Retinal fundus photograph — 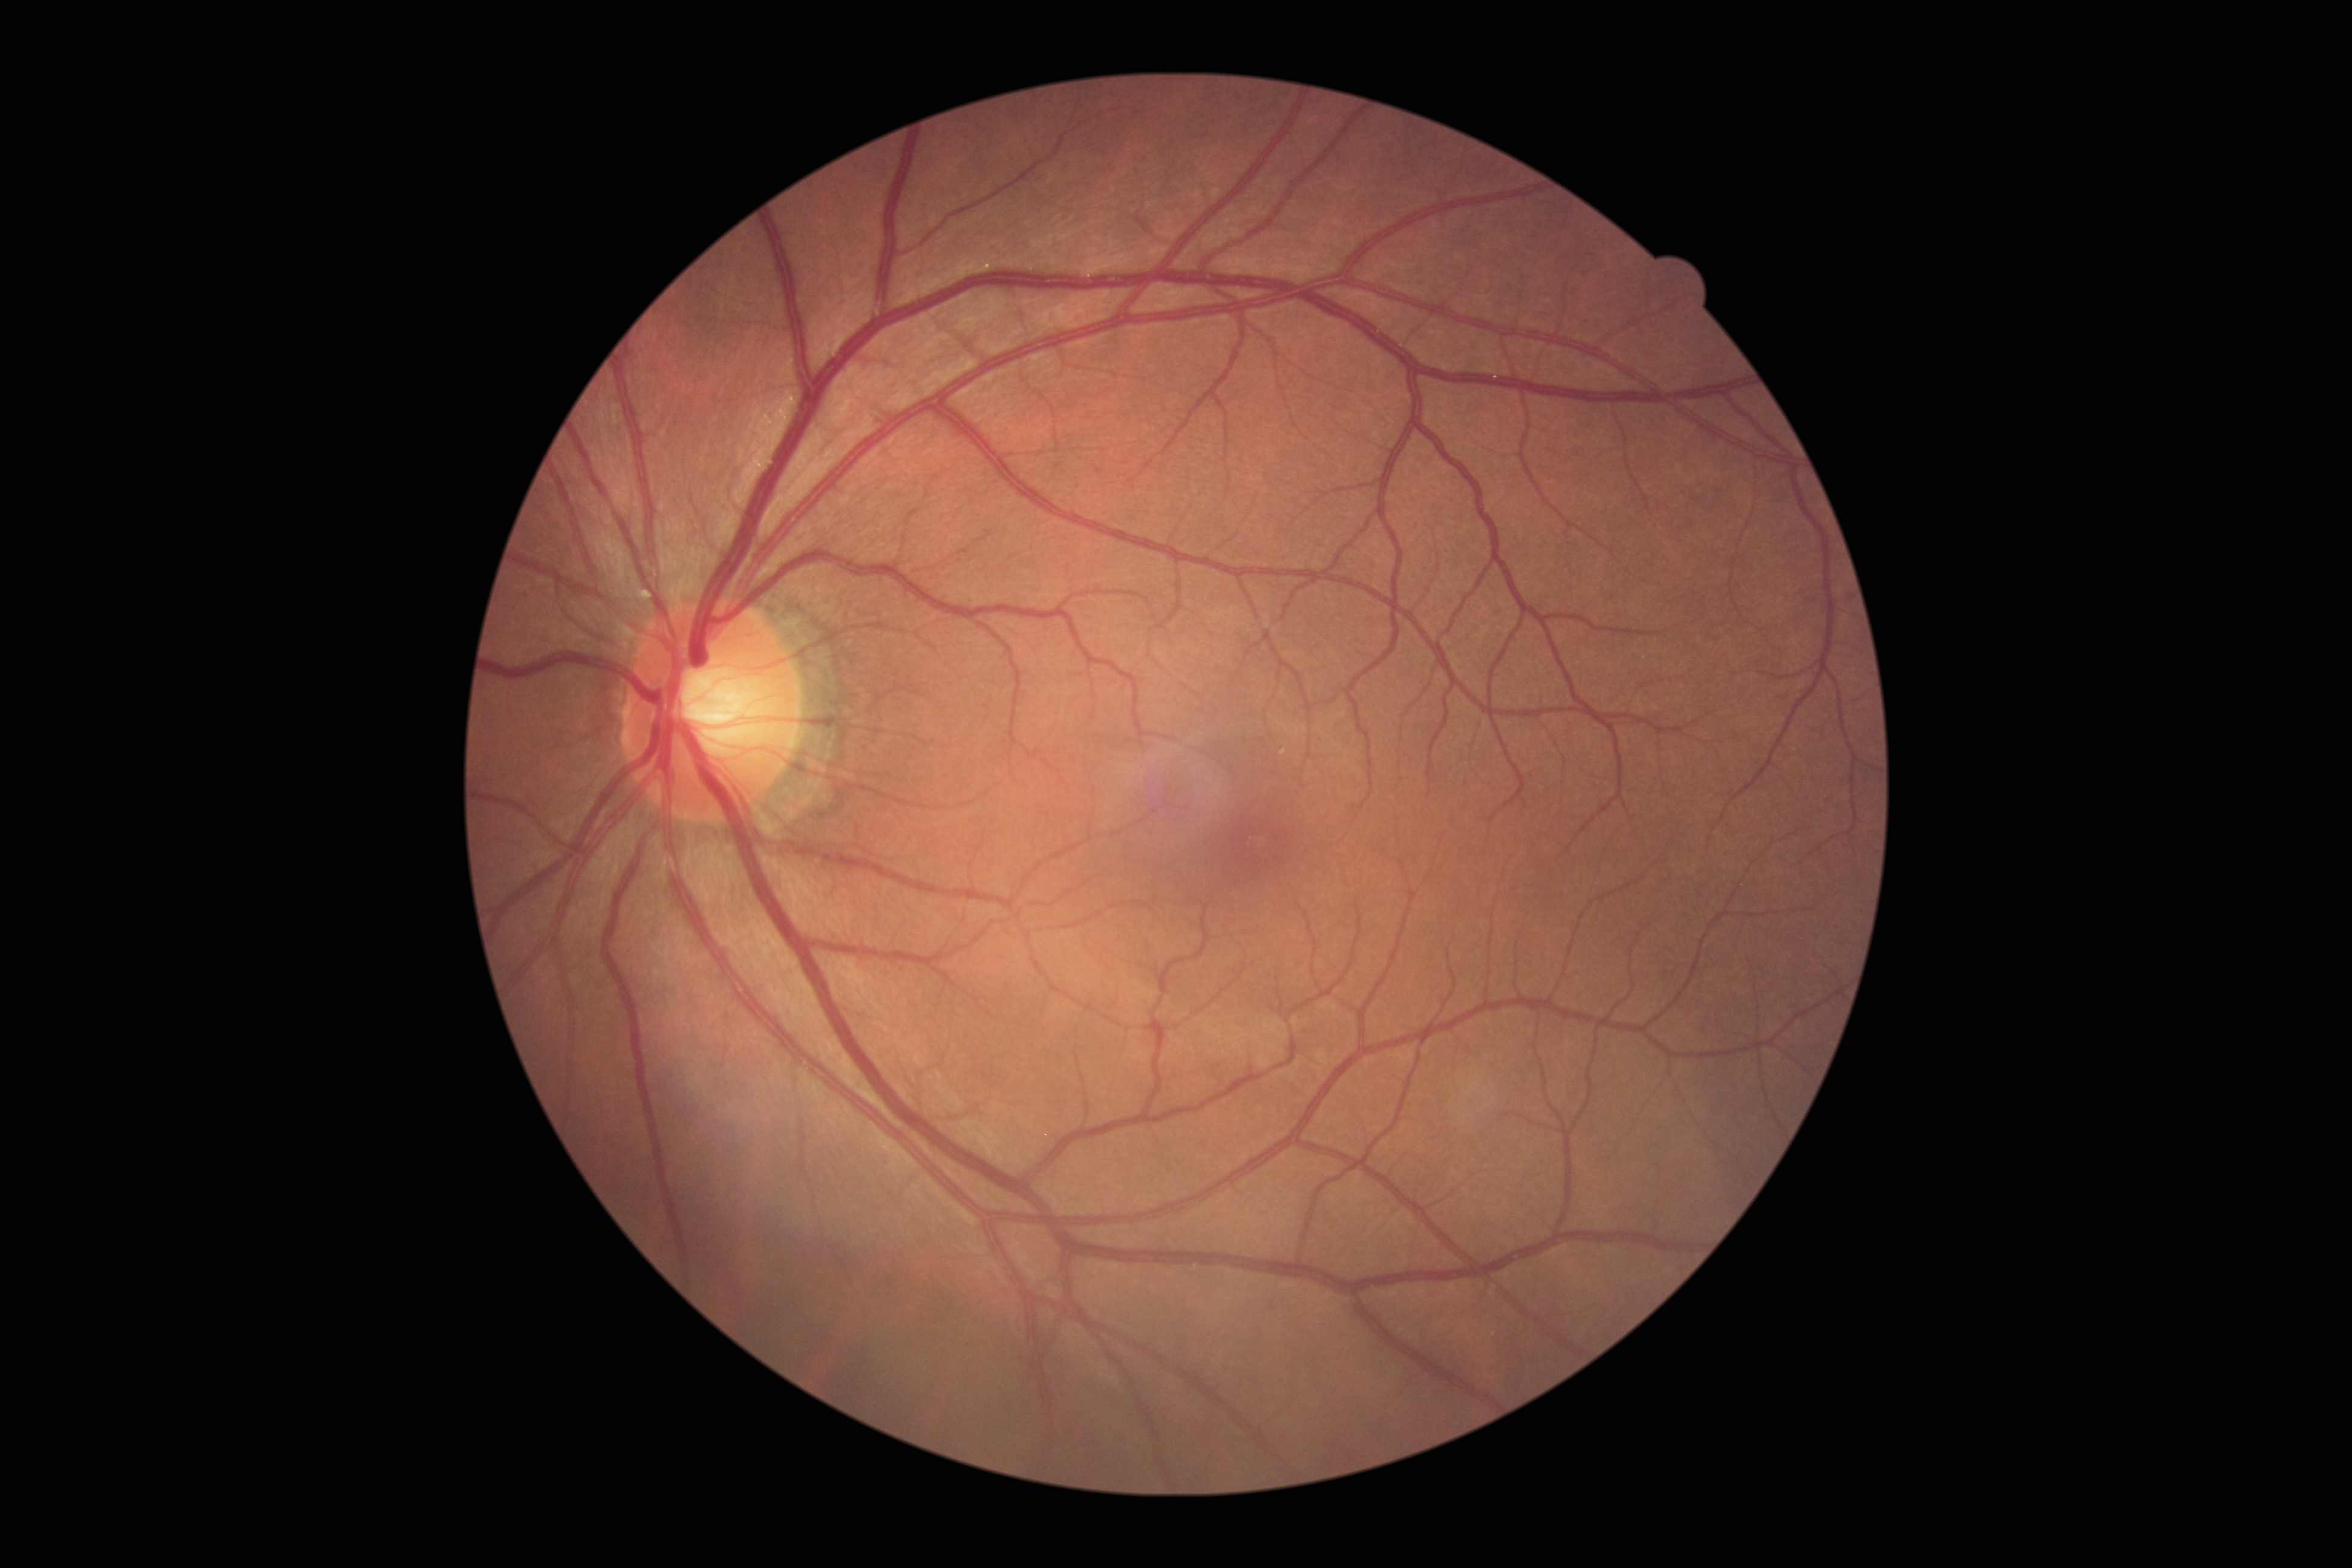
DR grade: no apparent retinopathy (0).